848 x 848 pixels · acquired with a NIDEK AFC-230 · 45° FOV: 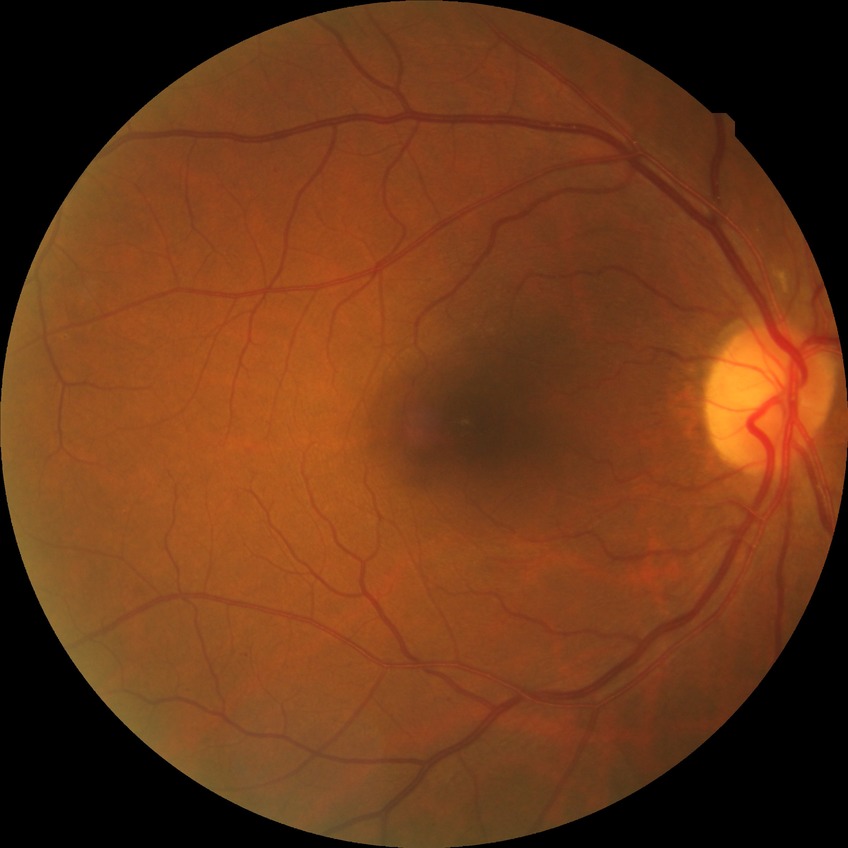 Diabetic retinopathy stage is no diabetic retinopathy.